Color fundus photograph — 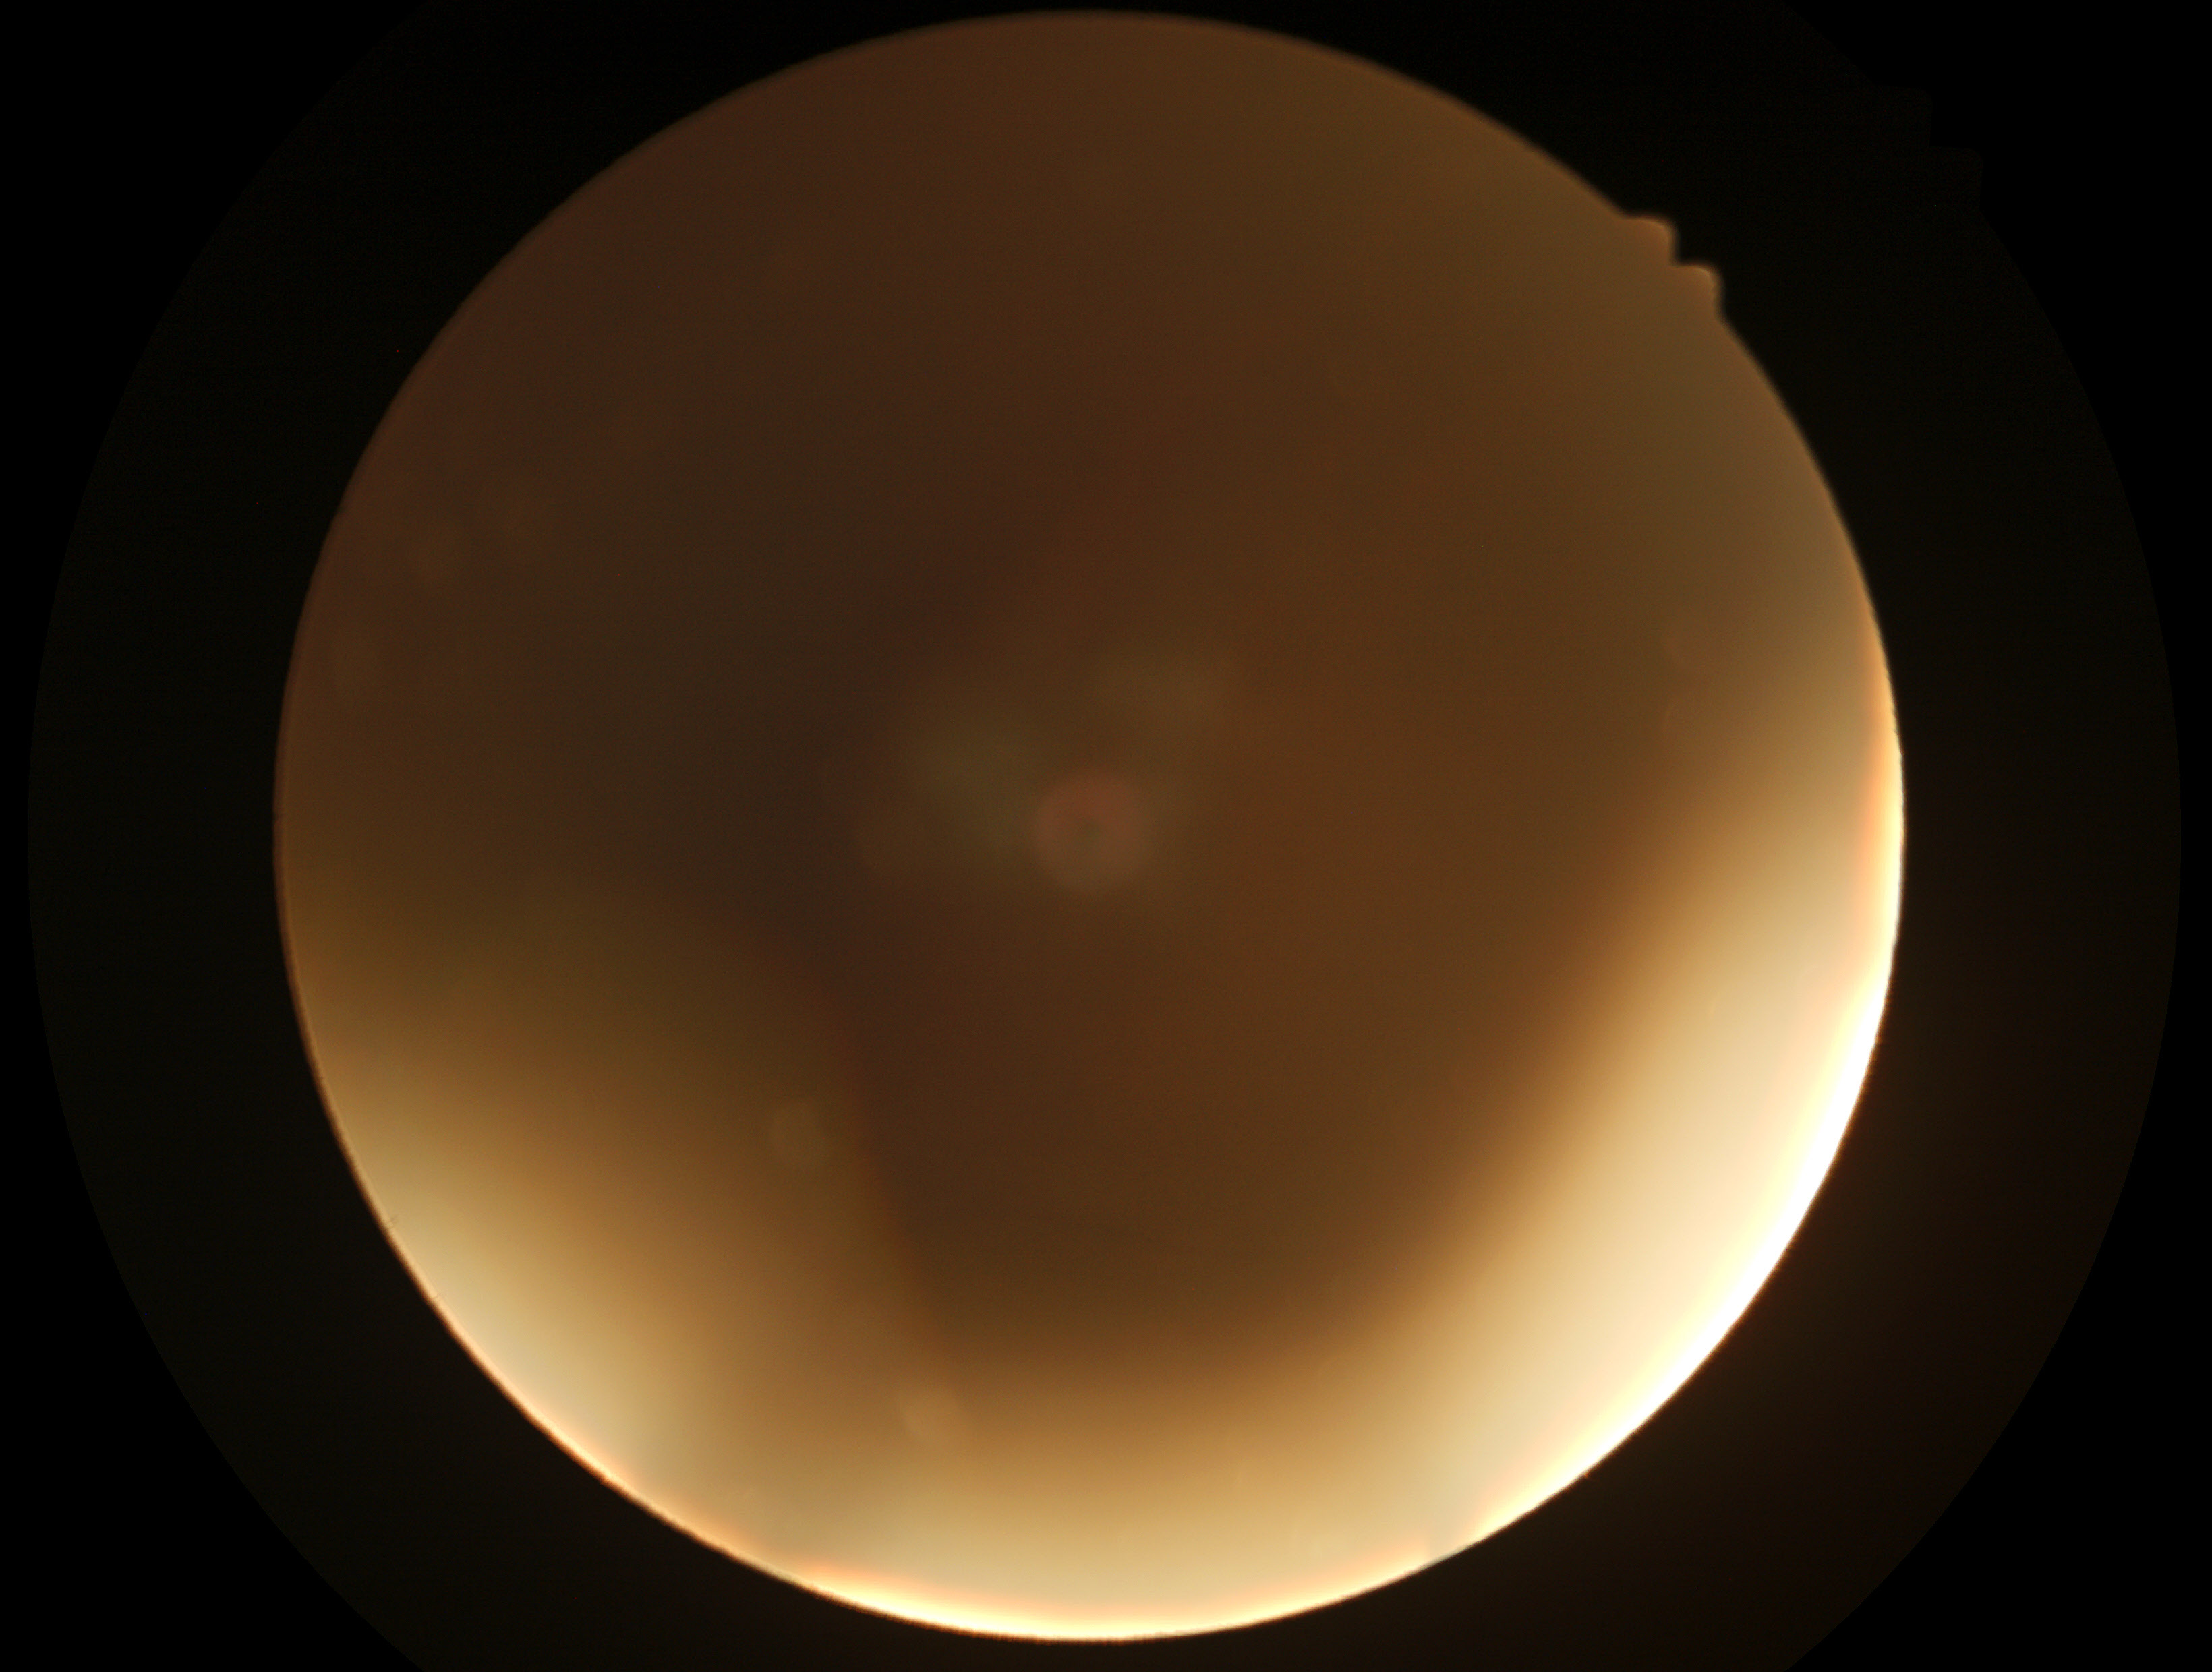

The image cannot be graded for diabetic retinopathy.
Retinopathy grade: ungradable due to poor image quality.